45° field of view. Fundus photo — 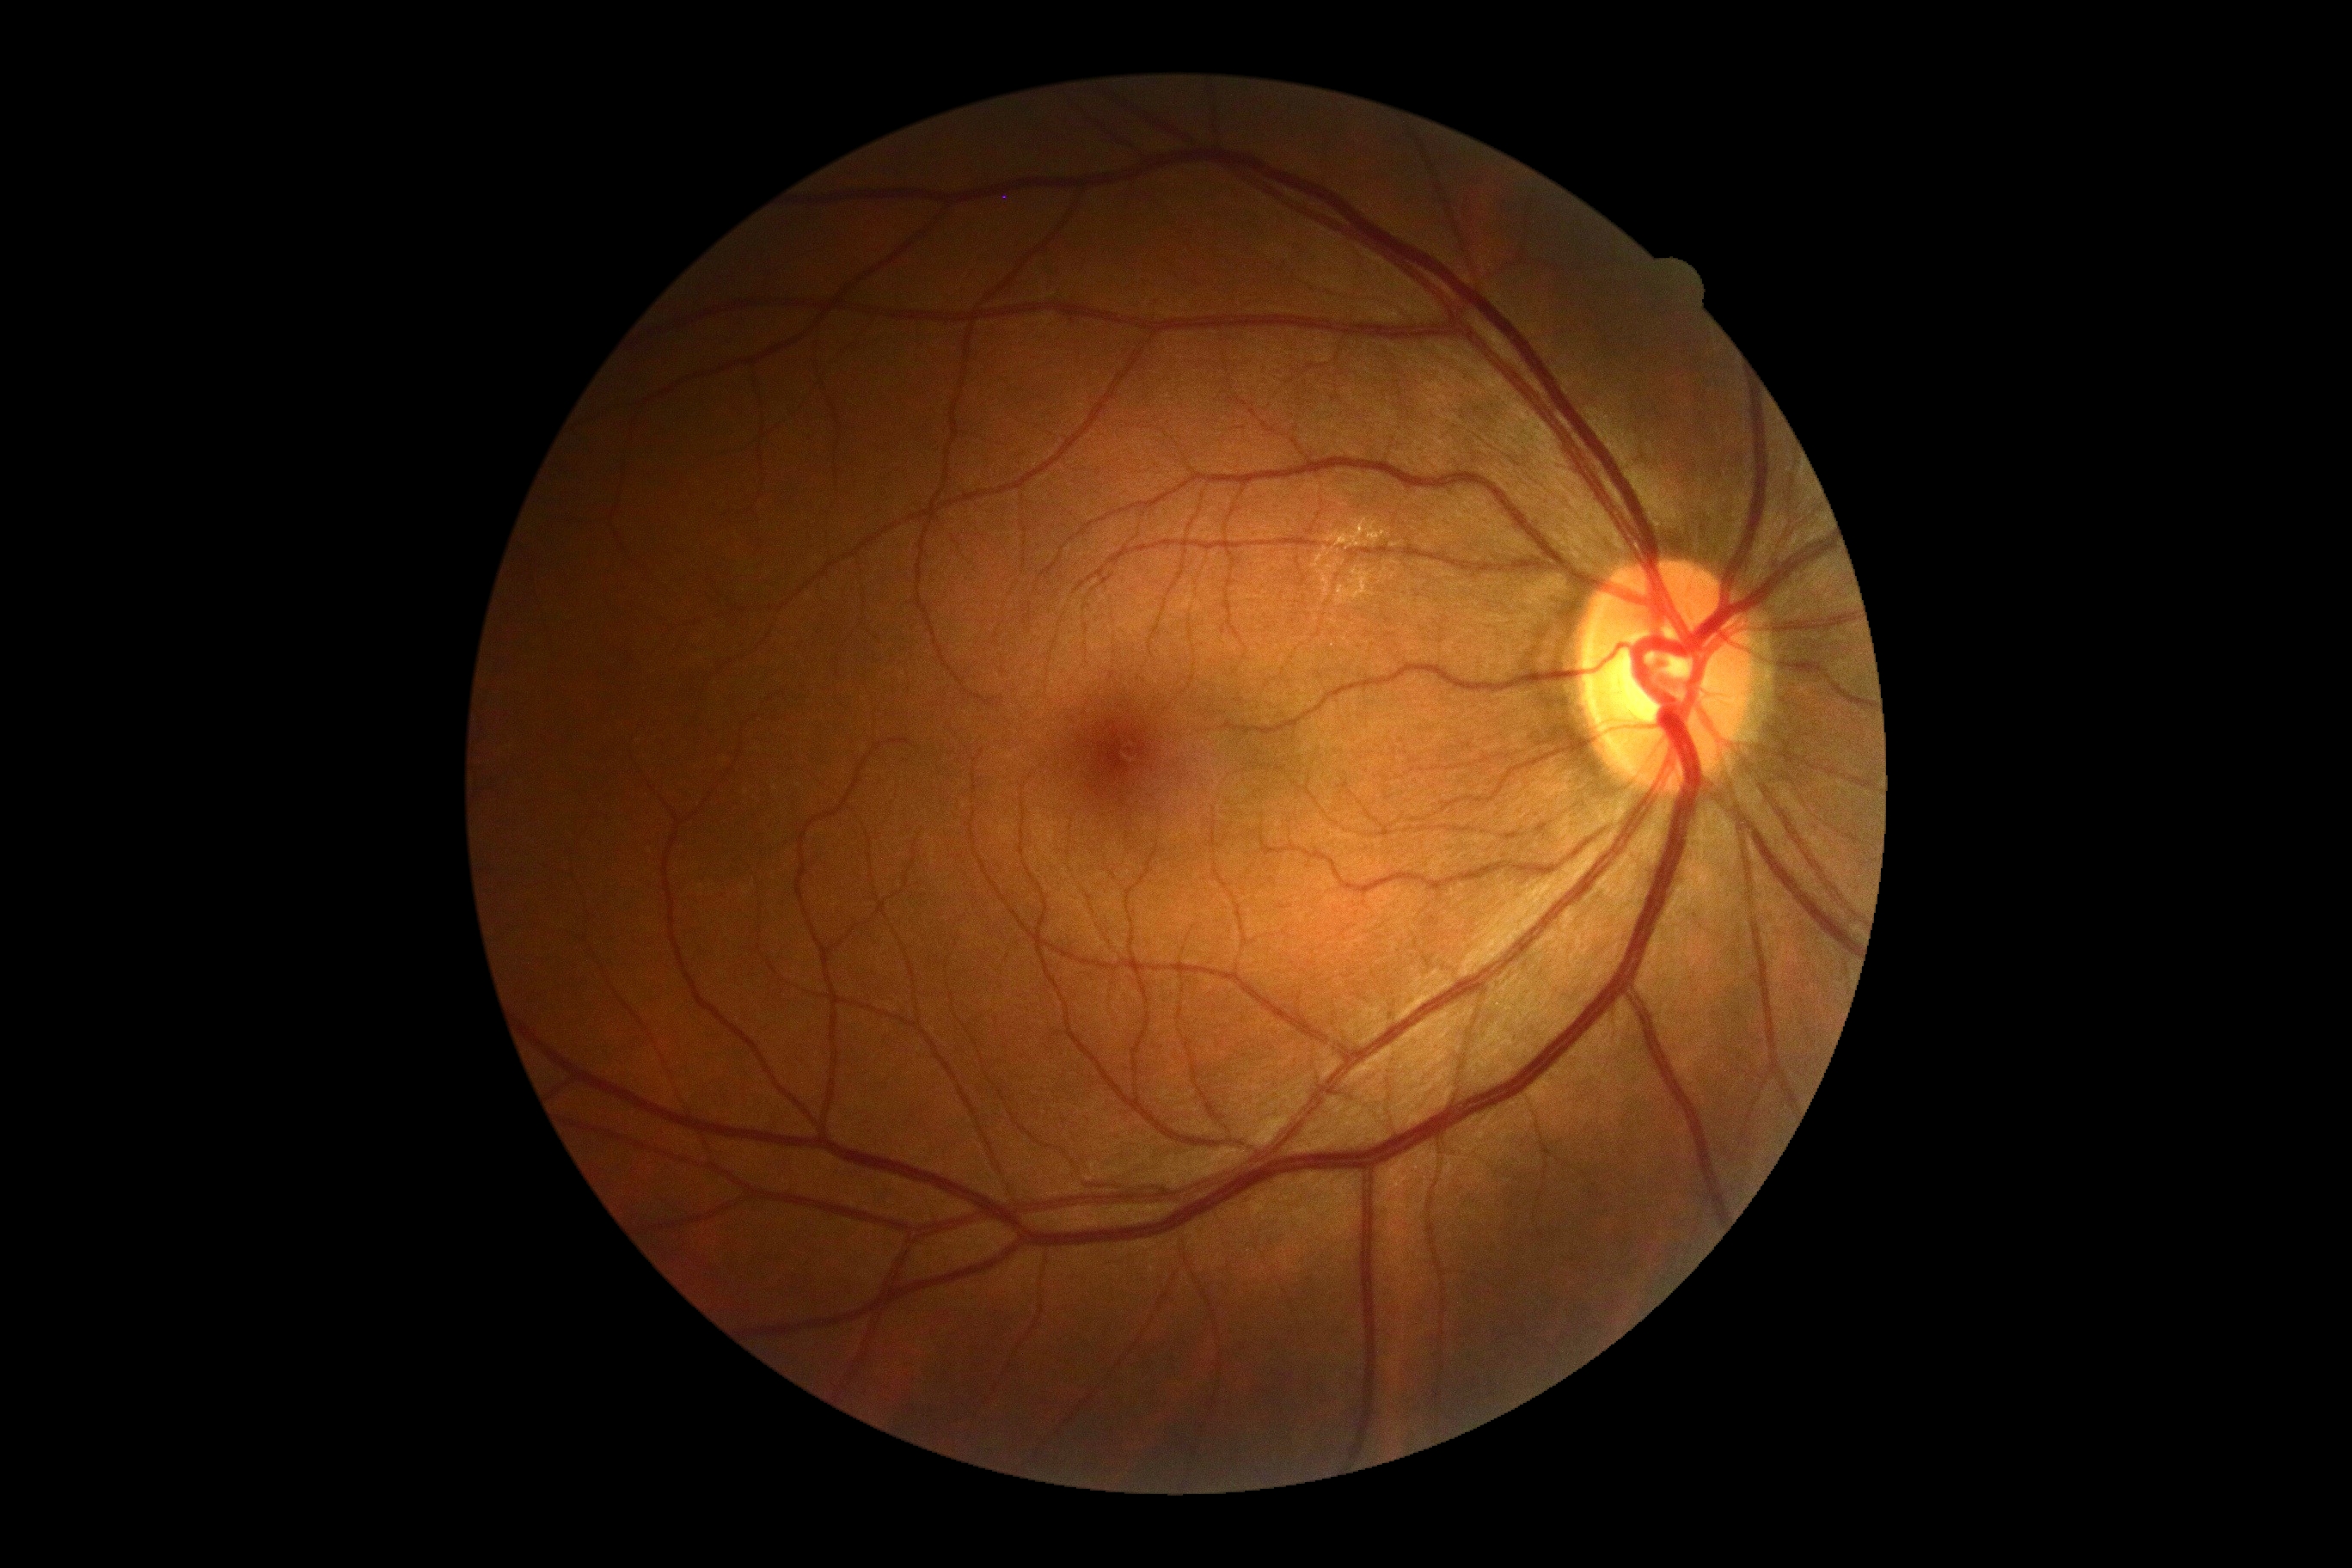

Retinopathy grade is 0. No diabetic retinal disease findings.